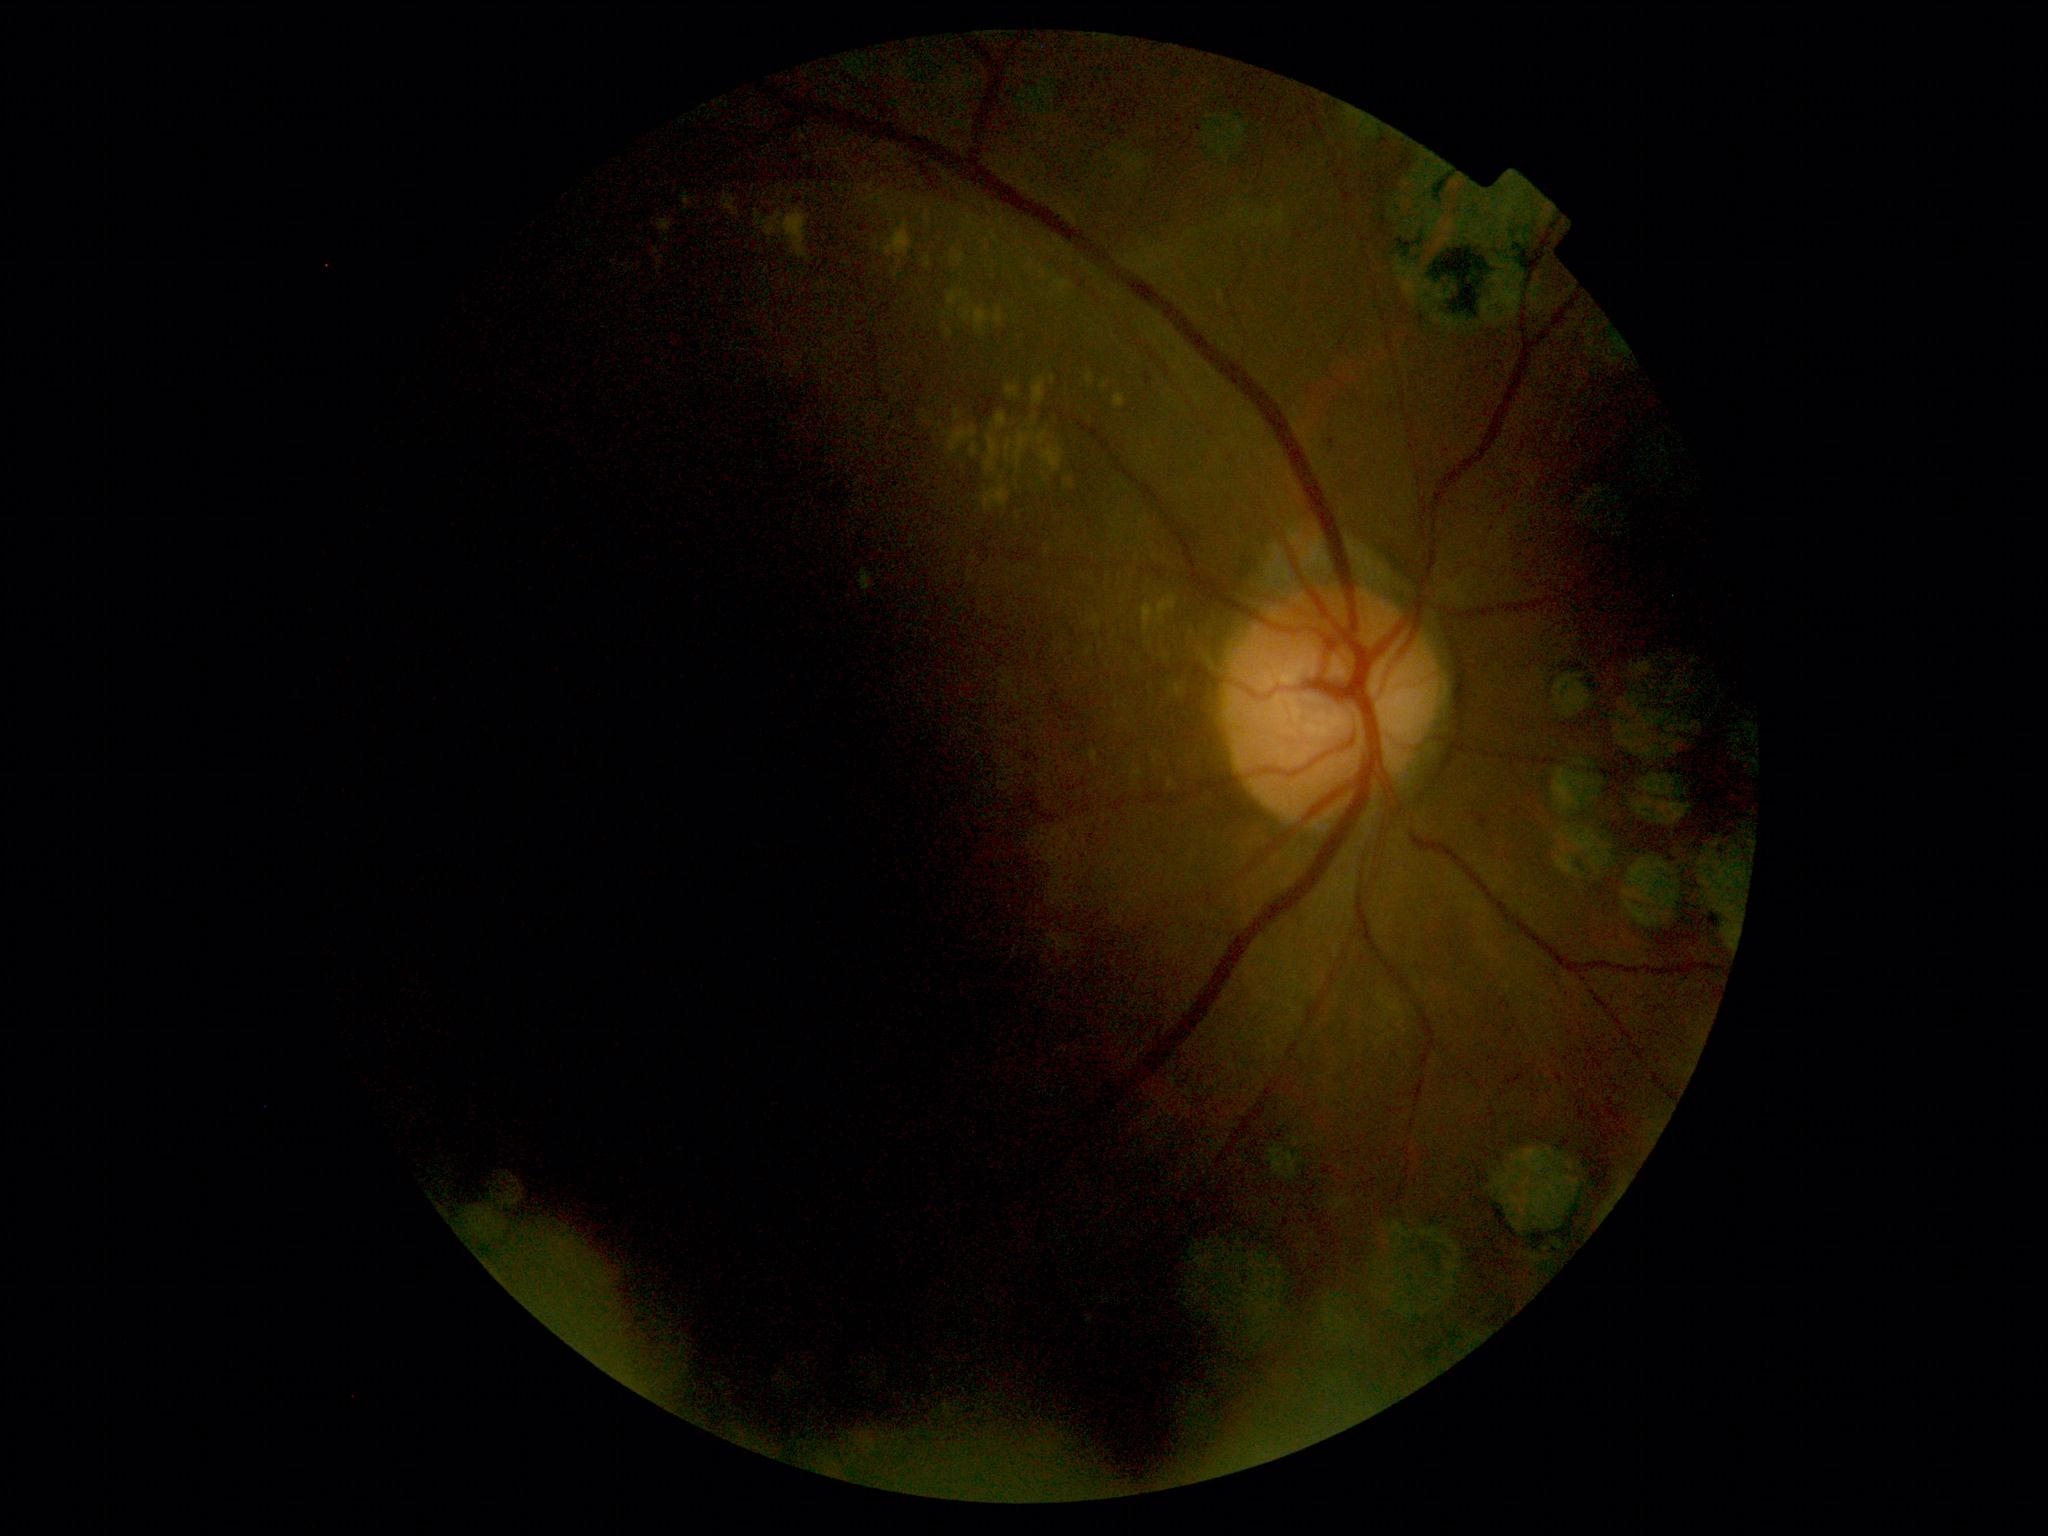 Diabetic retinopathy severity is grade 2 (moderate NPDR).